Captured with the Clarity RetCam 3 (130° field of view); image size 640x480; infant wide-field retinal image:
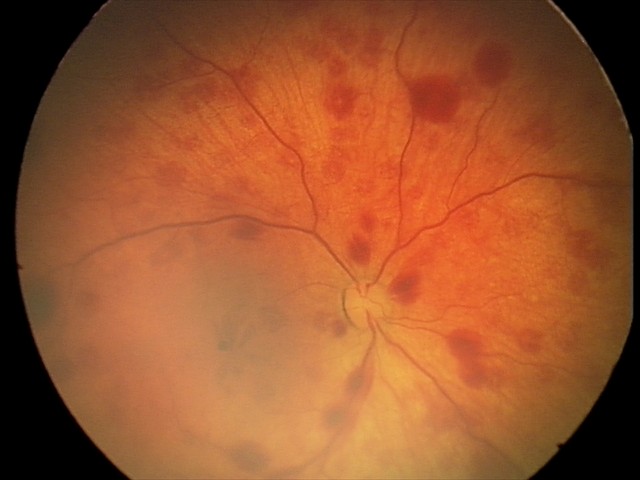

From an examination with diagnosis of retinal hemorrhages.